FOV: 45 degrees. Fundus photo. 1932x1916 — 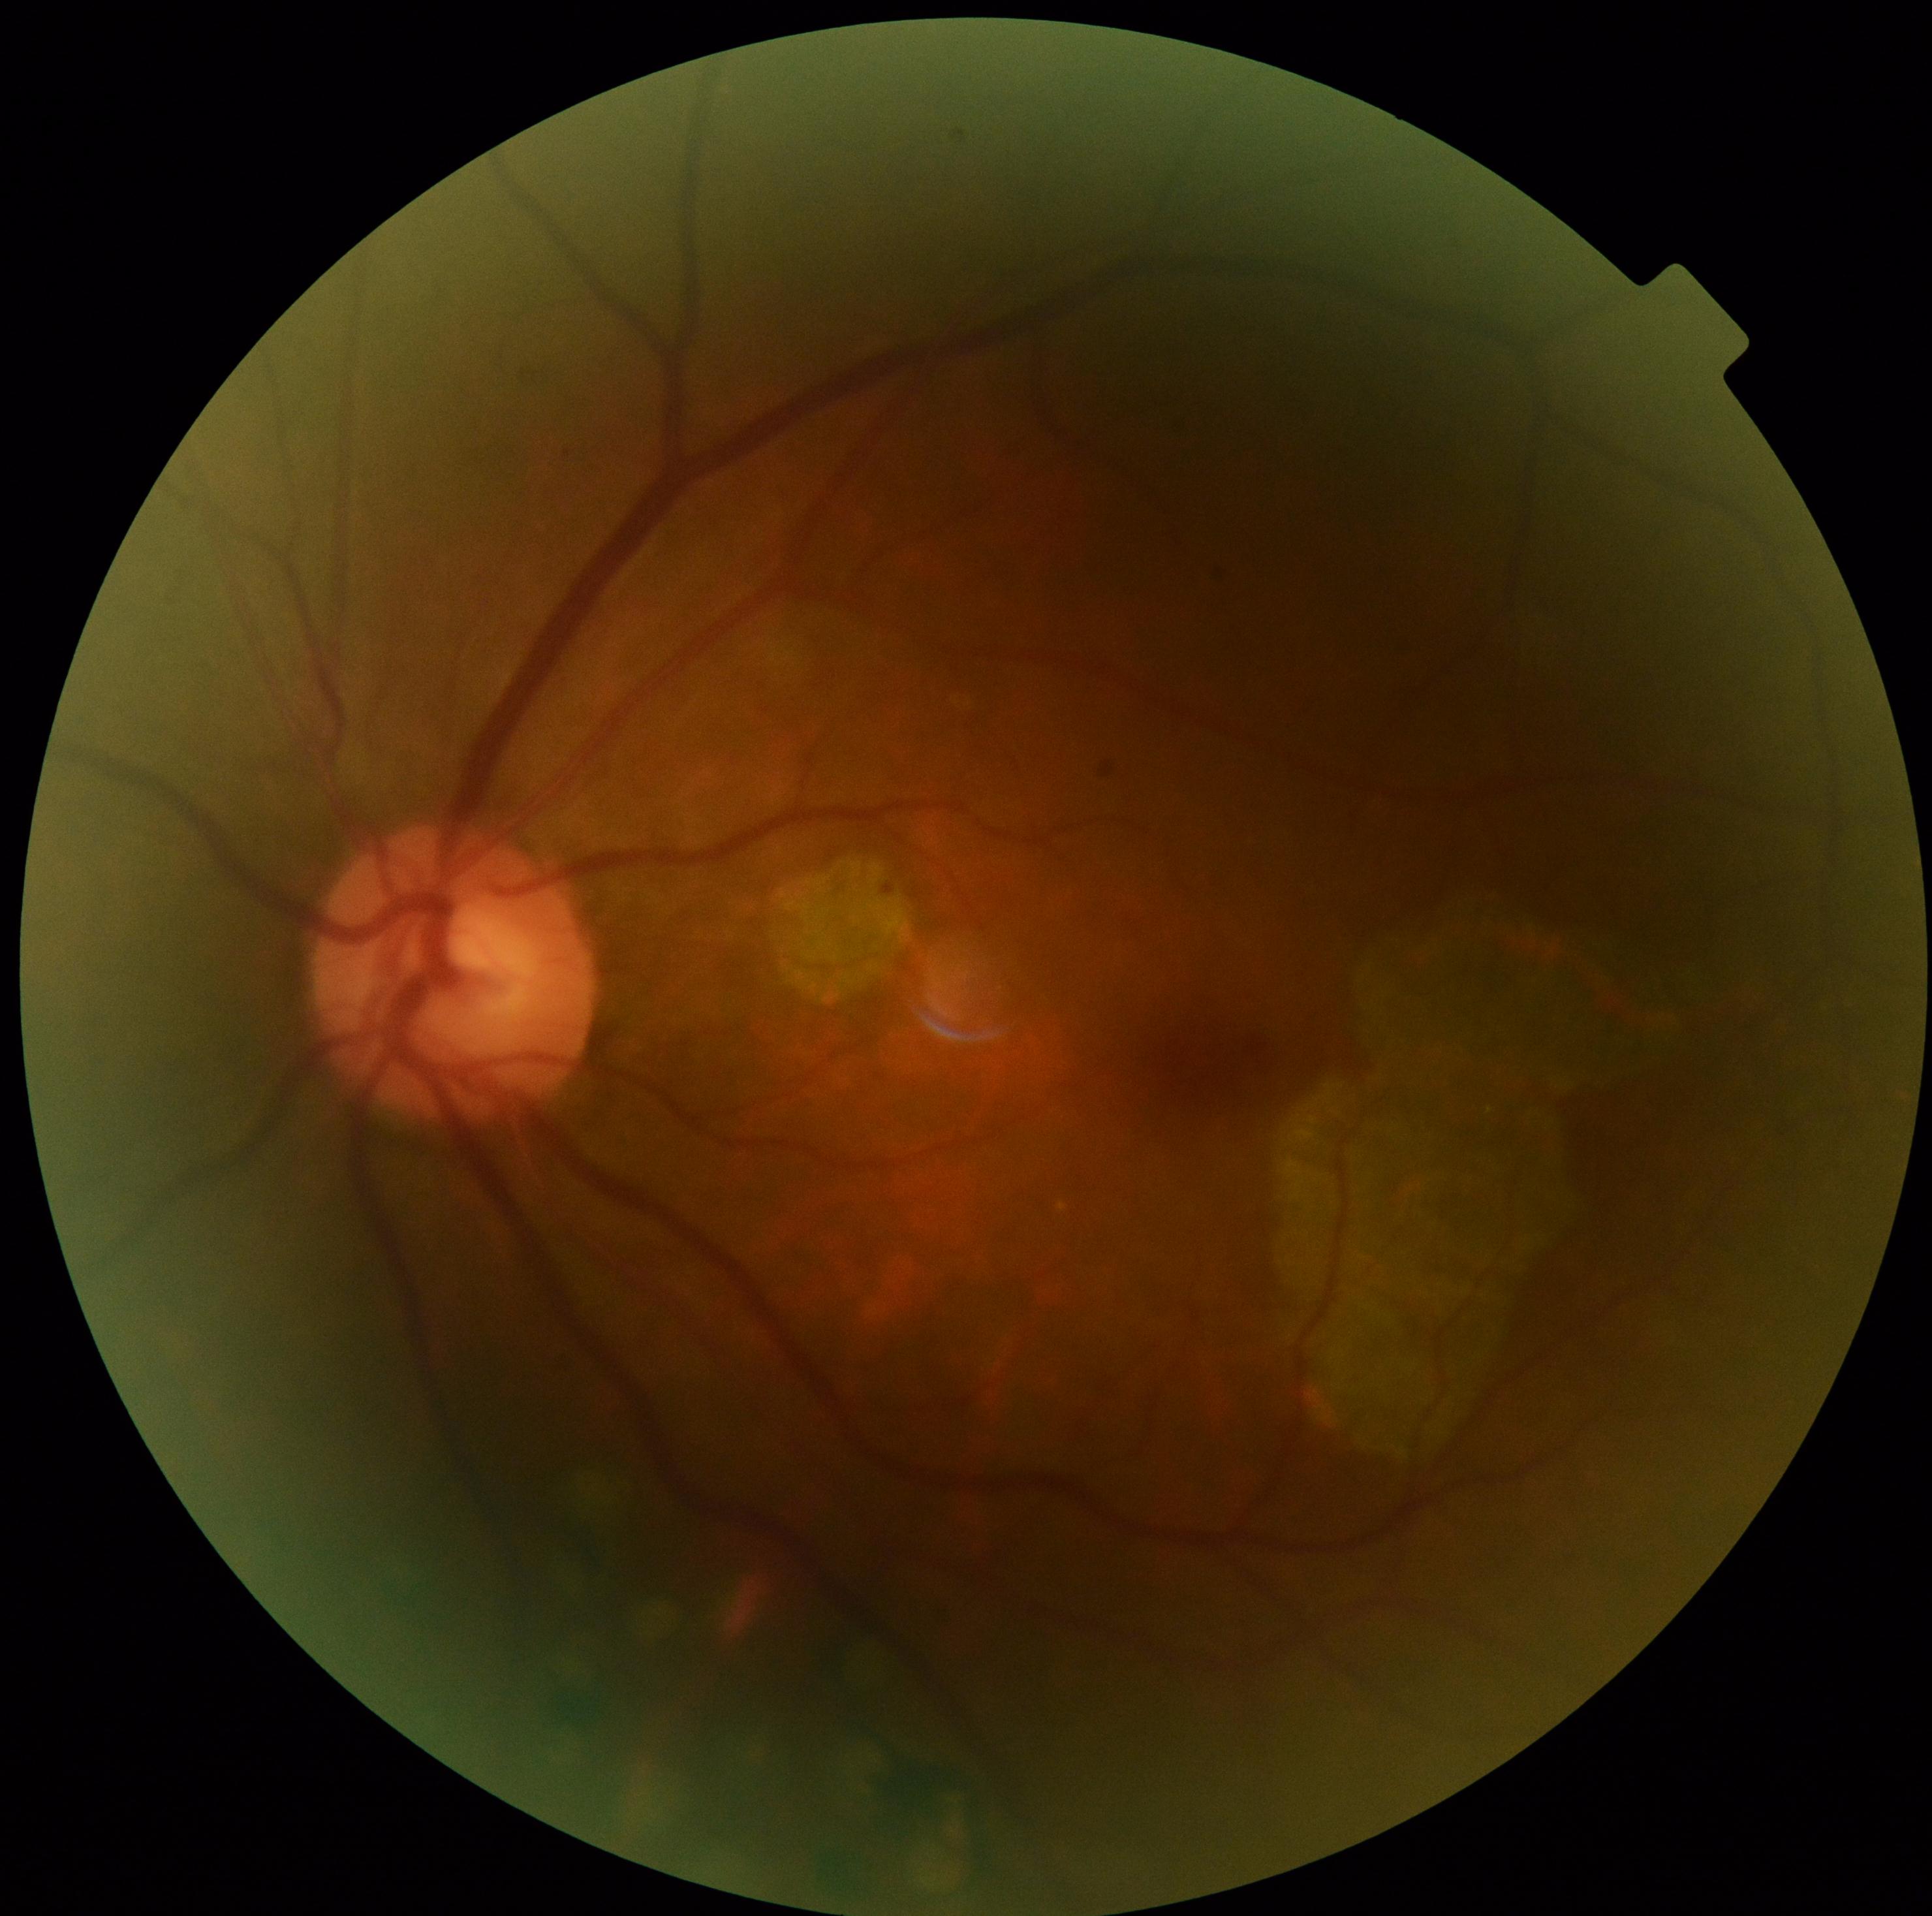 Annotations:
- retinopathy — grade 1 (mild NPDR)